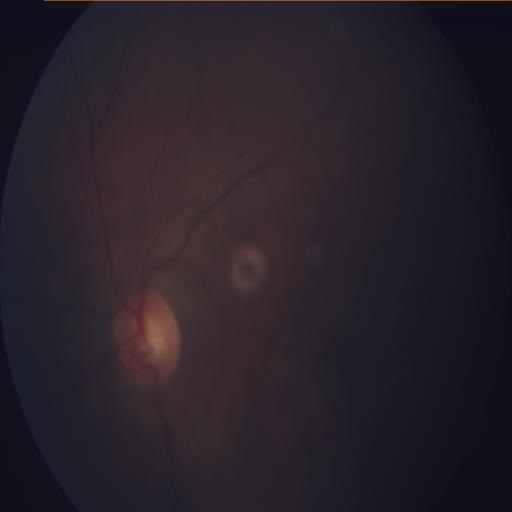
Fundus image with findings of media haze.